Infant wide-field retinal image · acquired on the Clarity RetCam 3 — 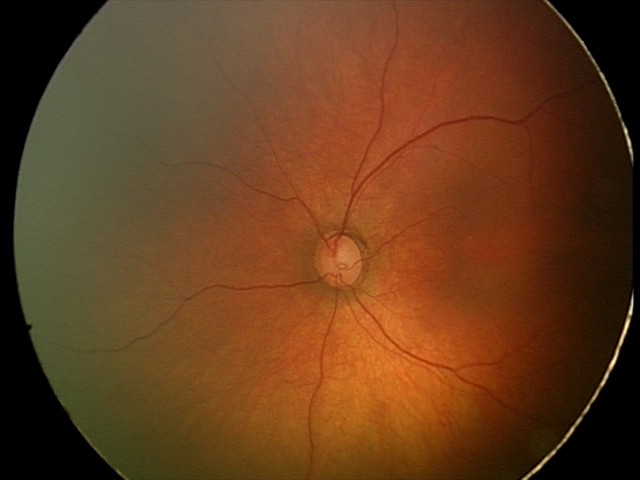 Screening diagnosis: no pathology identified.